2352 by 1568 pixels.
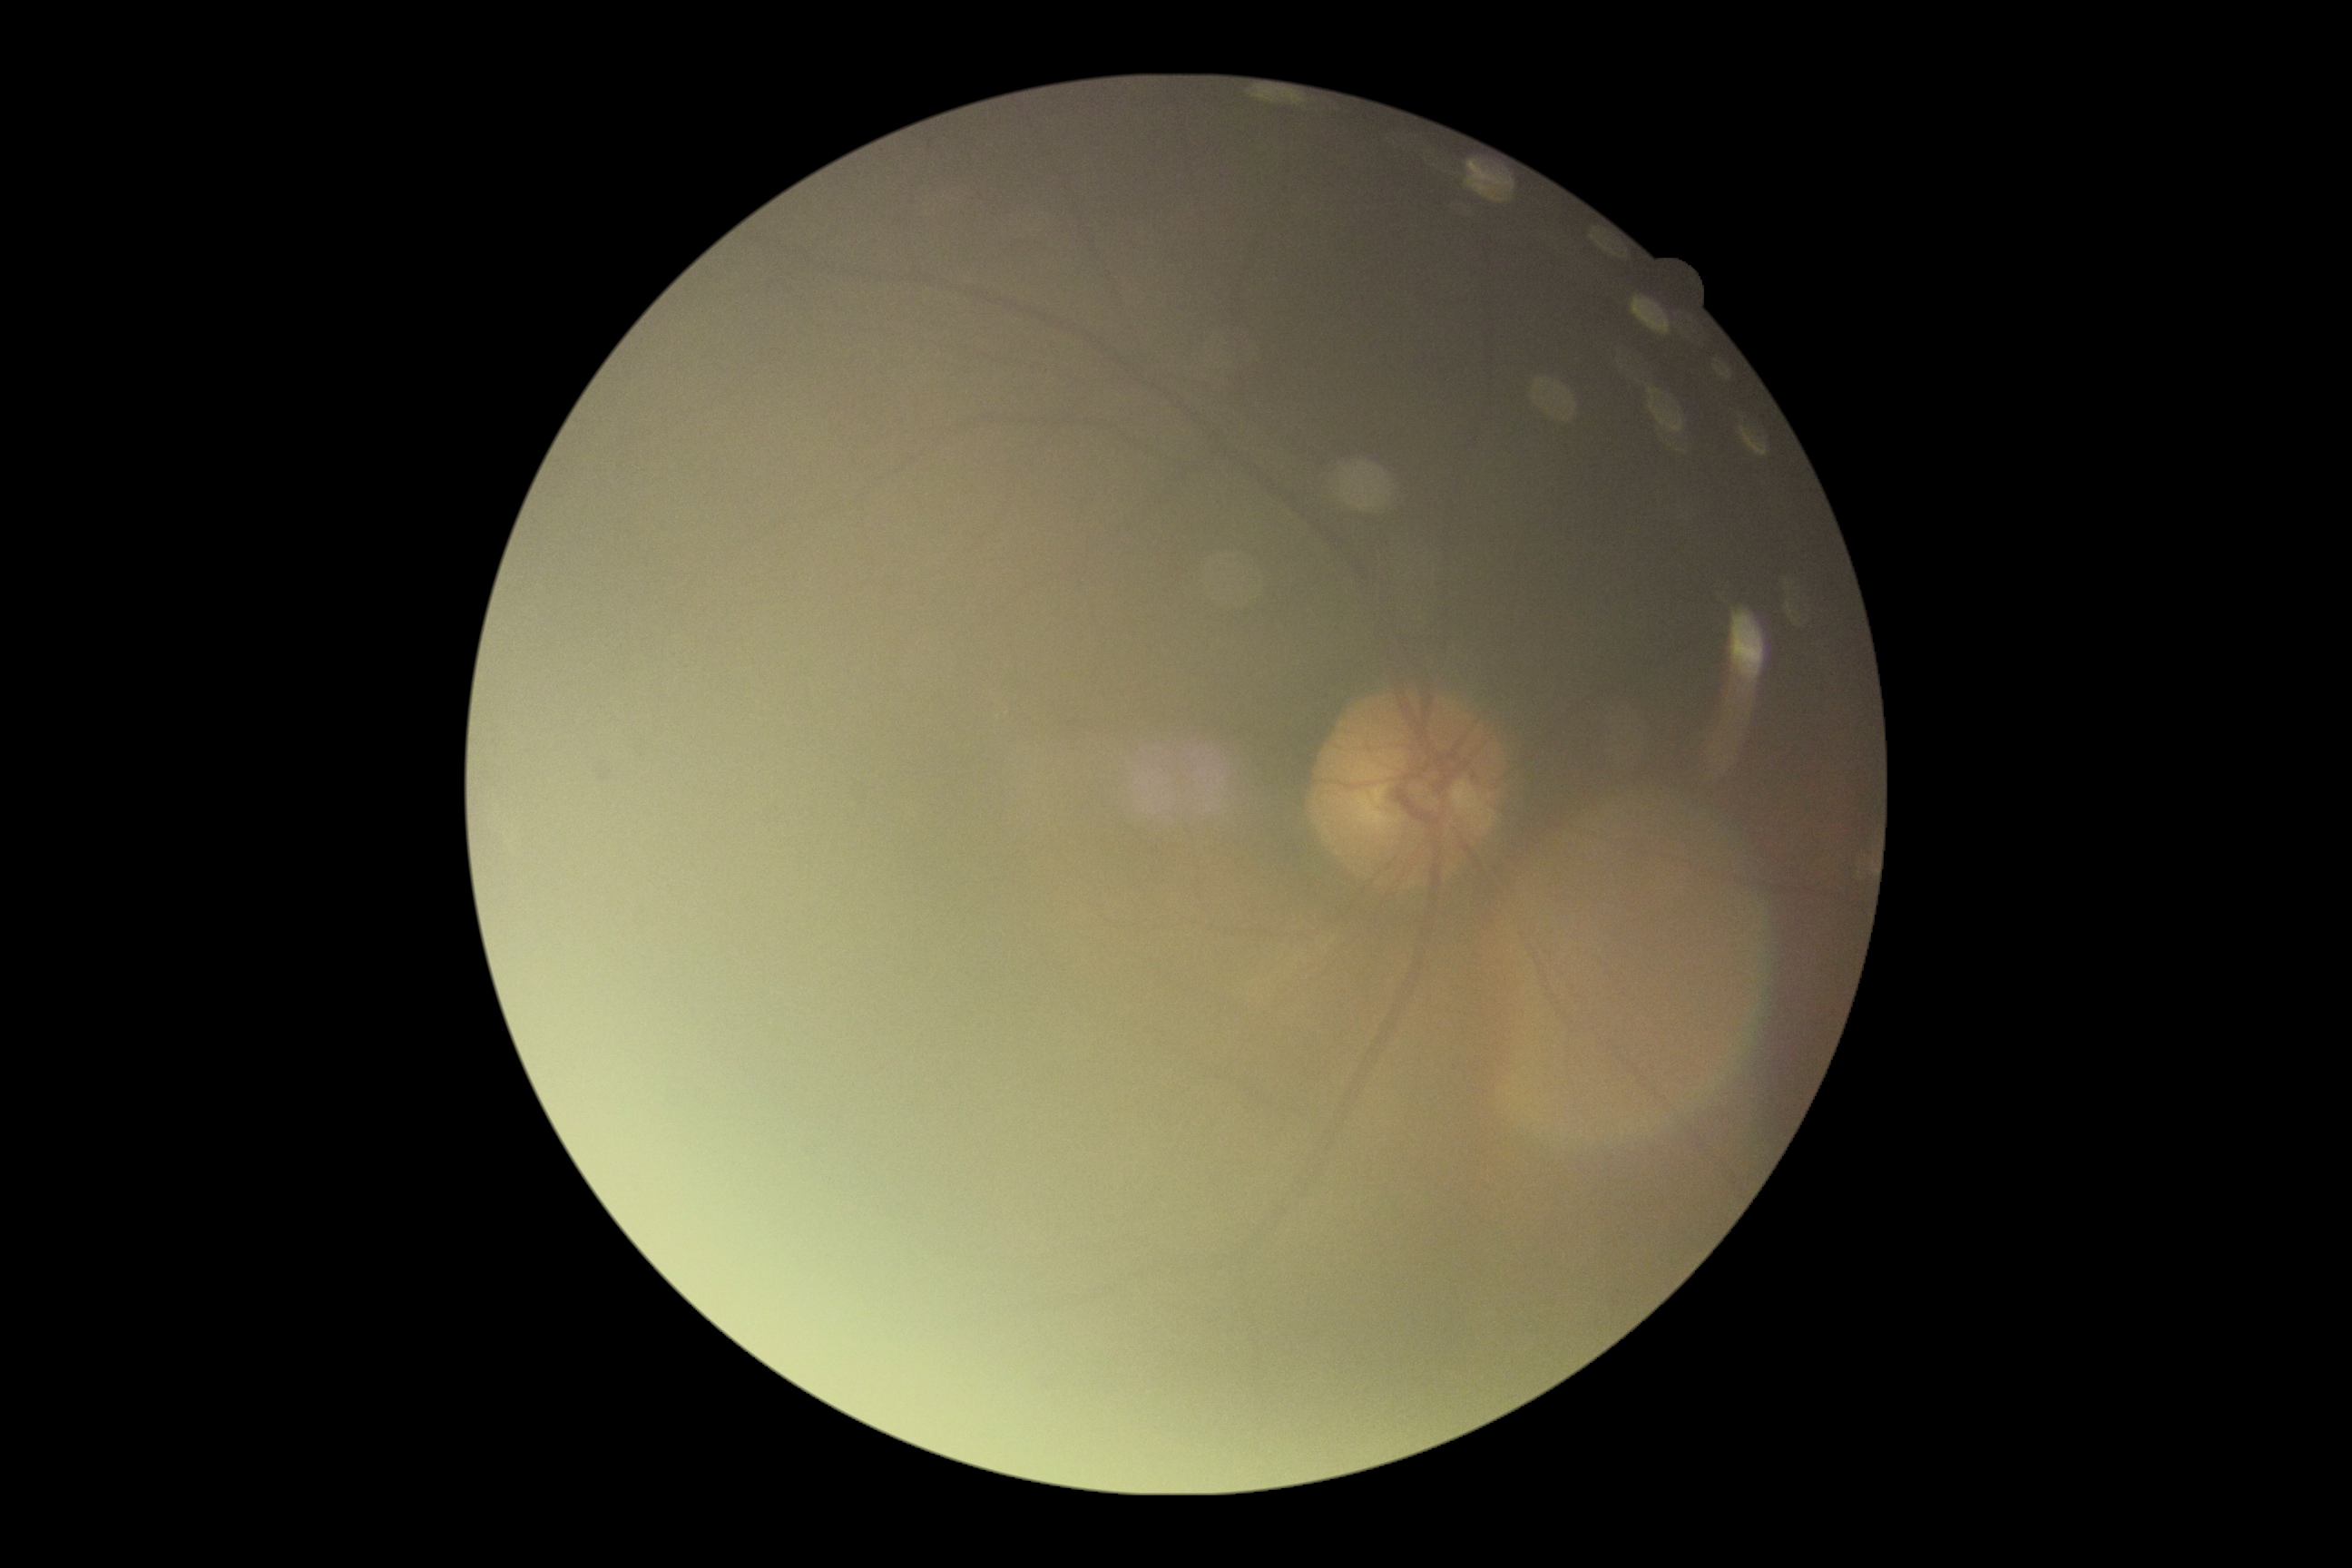

DR: ungradable due to poor image quality.